Wide-field fundus photograph from neonatal ROP screening.
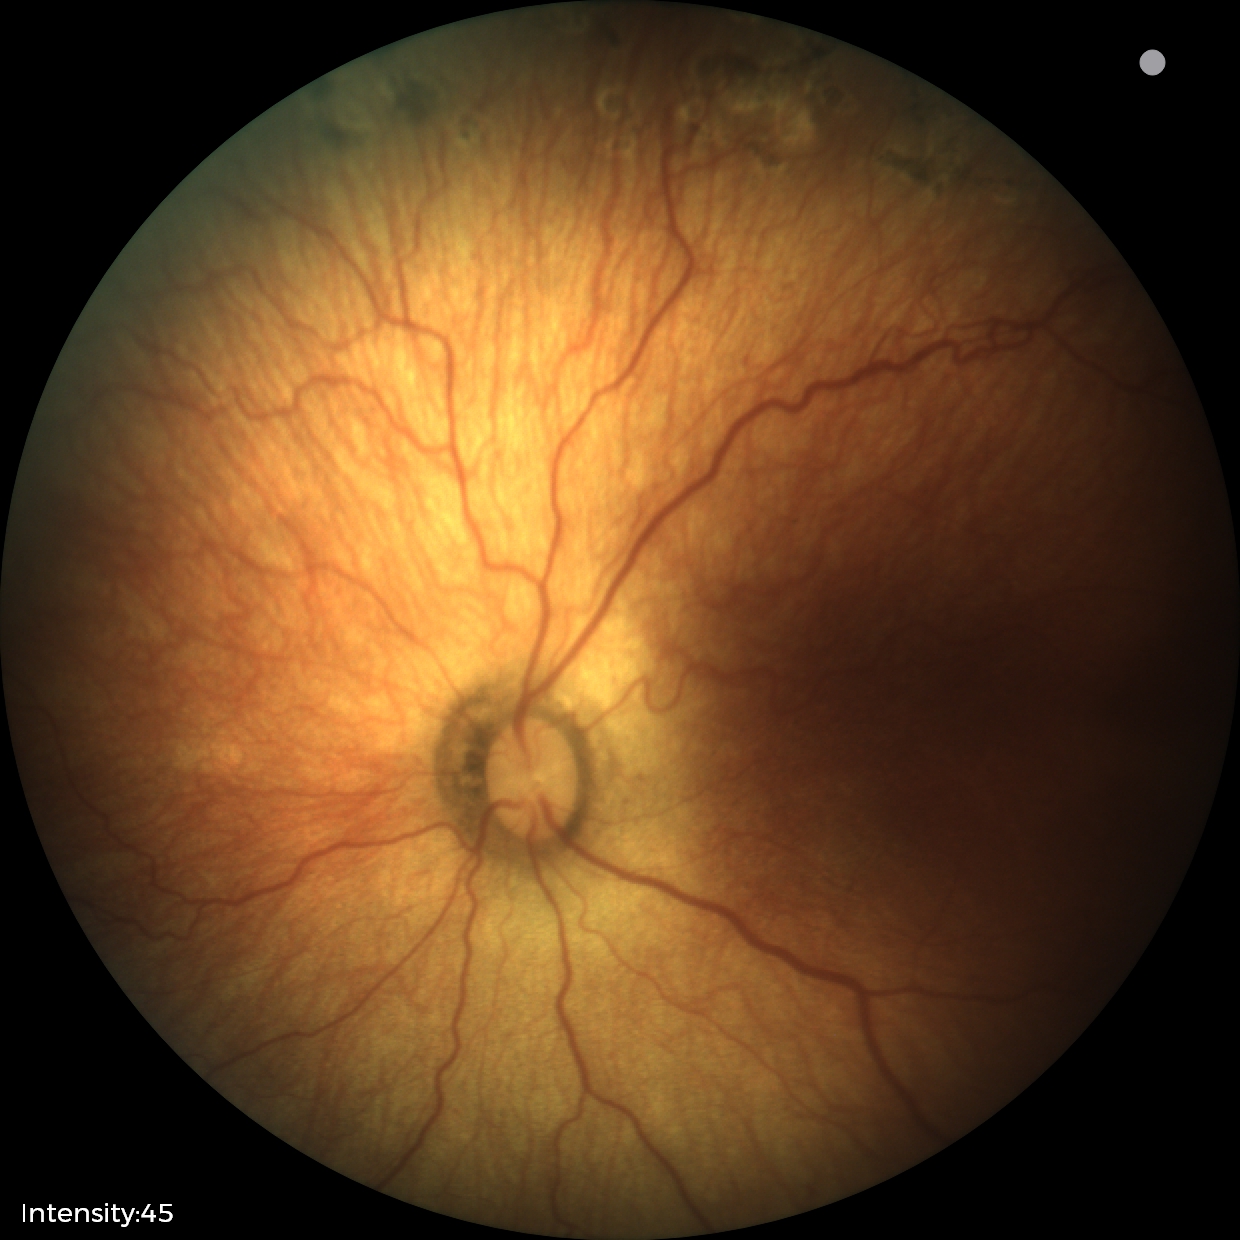

No plus disease.
Examination diagnosed as status post ROP.